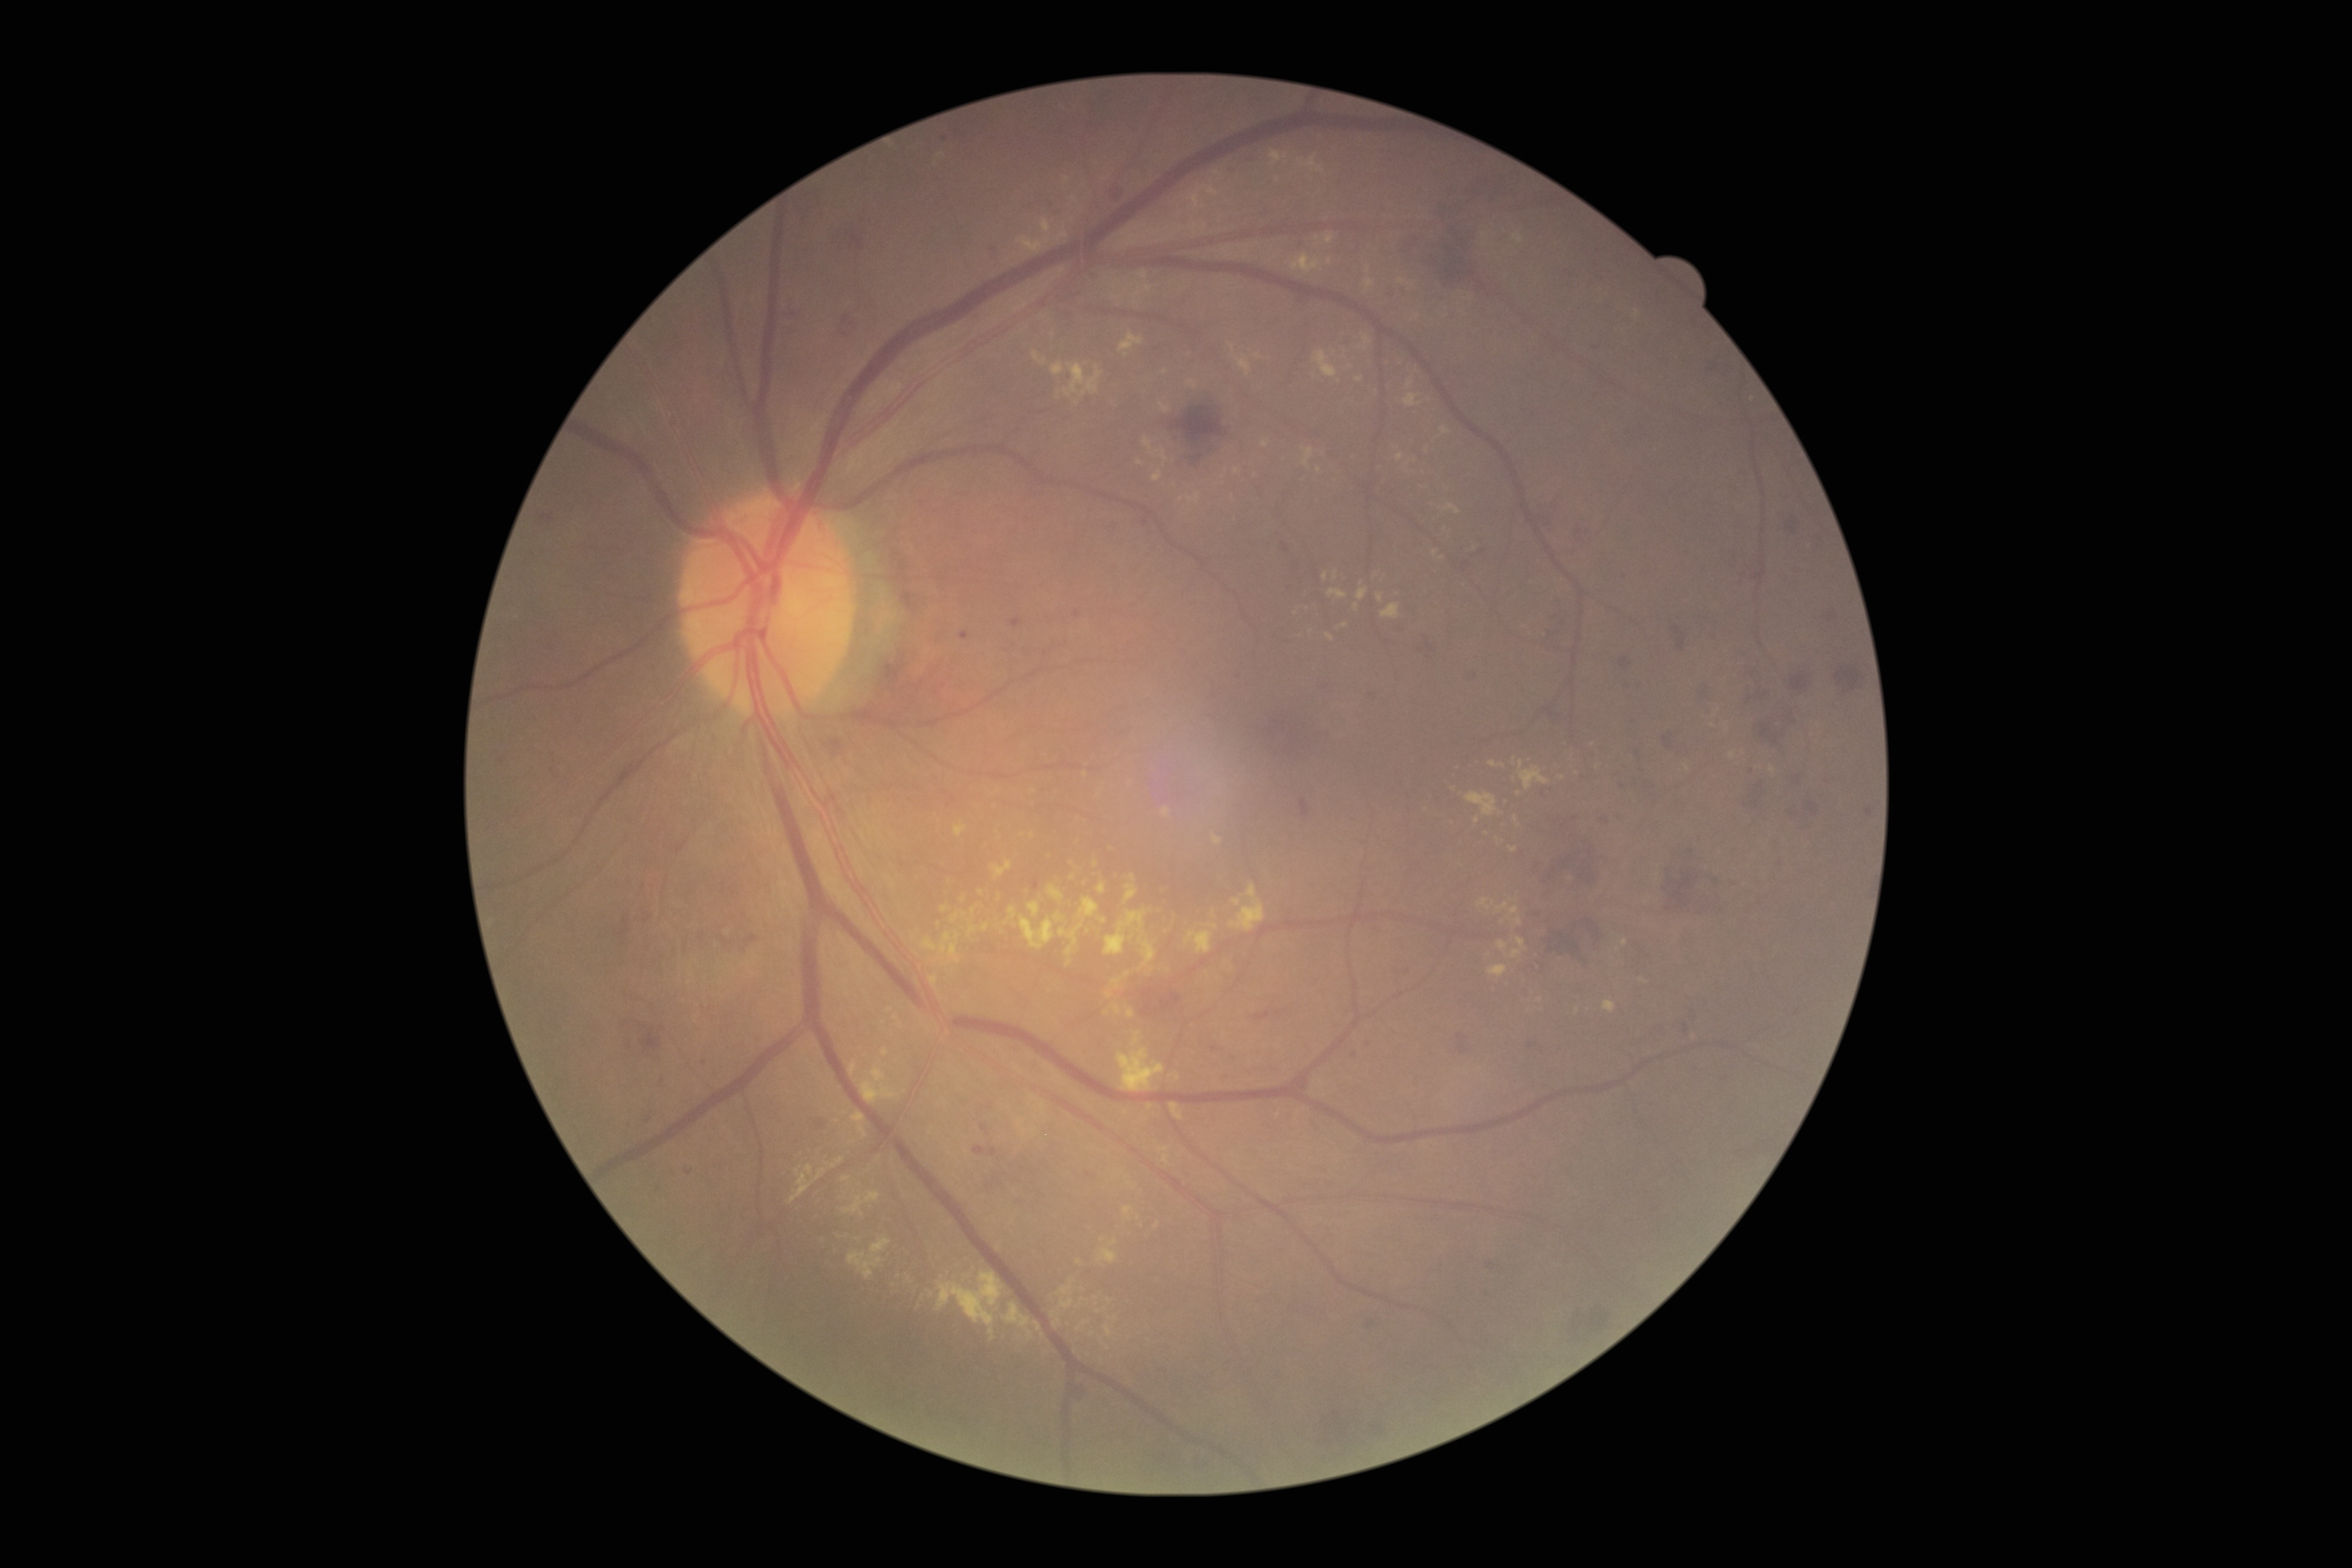
Diabetic retinopathy grade: moderate non-proliferative diabetic retinopathy (2)
Lesions identified (partial list):
hard exudates (continued): <bbox>1376, 593, 1383, 603</bbox> | <bbox>1161, 1146, 1169, 1152</bbox> | <bbox>1008, 907, 1017, 919</bbox> | <bbox>954, 822, 967, 838</bbox> | <bbox>1451, 821, 1459, 825</bbox> | <bbox>1513, 233, 1524, 245</bbox> | <bbox>1509, 846, 1517, 852</bbox> | <bbox>1313, 351, 1338, 378</bbox> | <bbox>1034, 1322, 1042, 1331</bbox> | <bbox>1019, 915, 1054, 950</bbox> | <bbox>991, 861, 1013, 879</bbox> | <bbox>1052, 362, 1064, 376</bbox>
Small hard exudates approximately at <pt>1150,1107</pt> | <pt>964,914</pt> | <pt>939,924</pt> | <pt>973,911</pt> | <pt>1102,1239</pt> | <pt>1258,357</pt>